1659x2212 · color fundus photograph · Remidio FOP fundus camera:
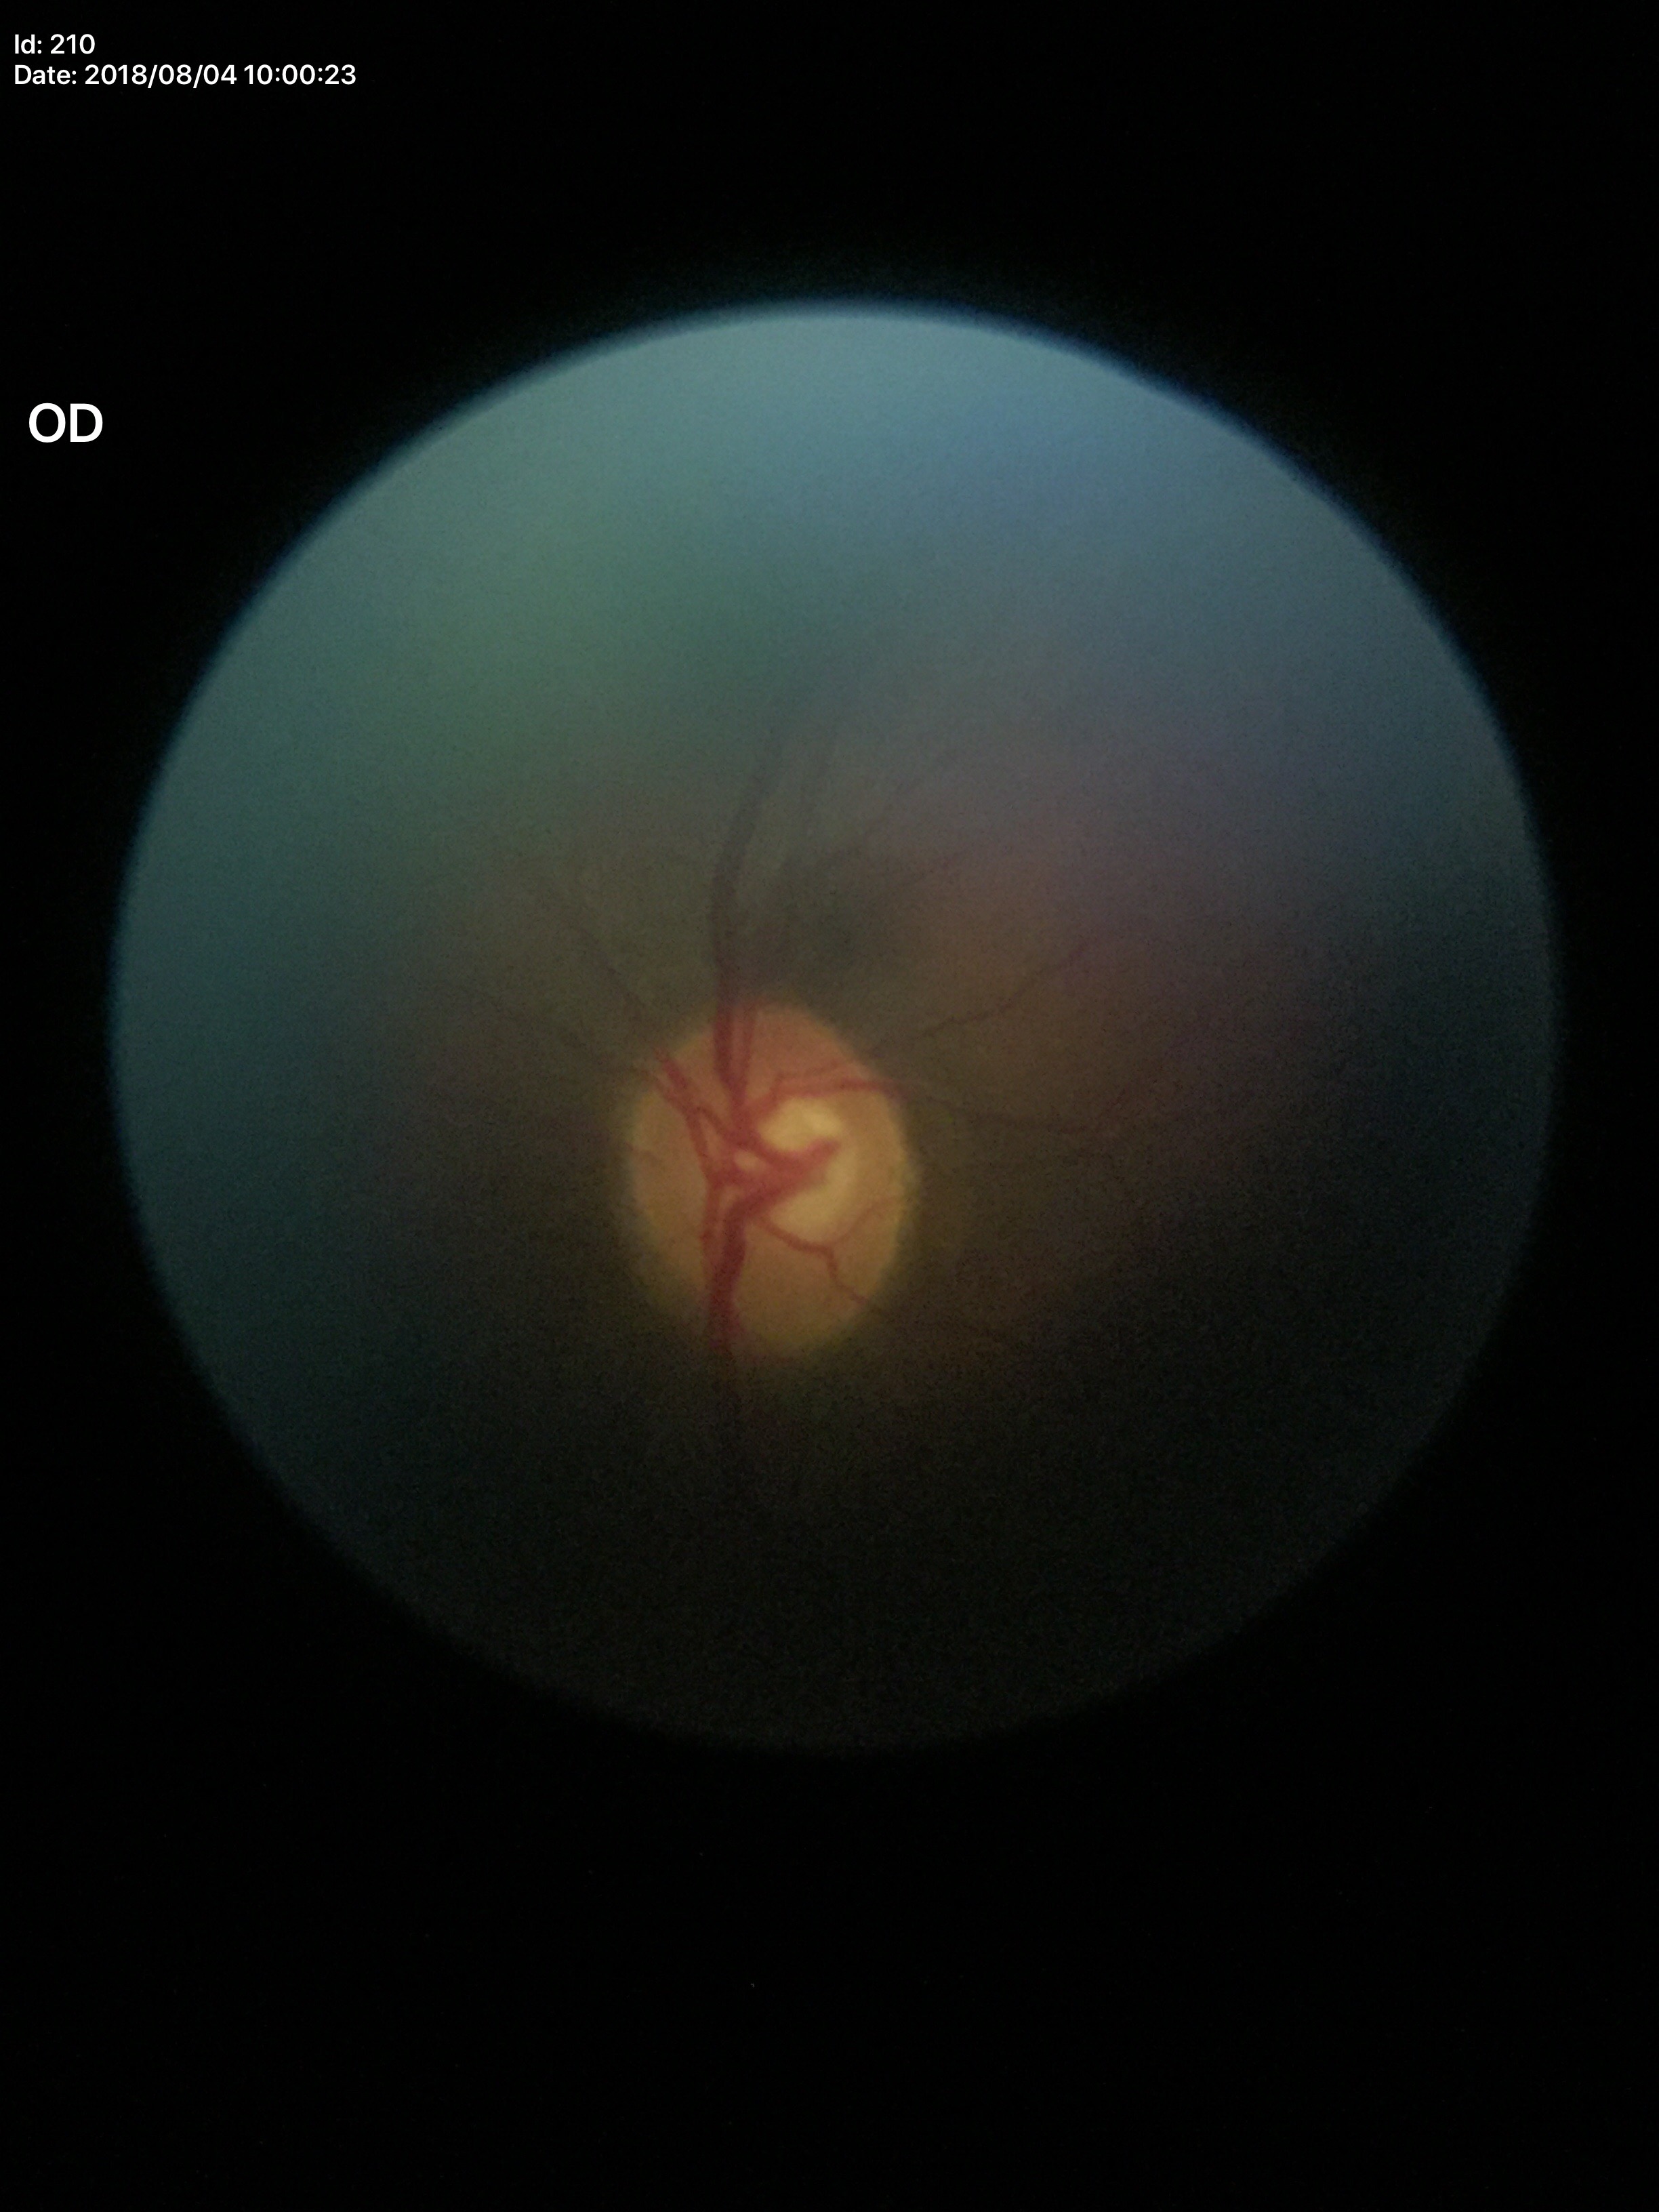
Q: Is there glaucoma suspicion?
A: not suspect (unanimous normal call)
Q: What is the vertical cup-to-disc ratio?
A: 0.54
Q: What is the horizontal cup-to-disc ratio?
A: 0.61